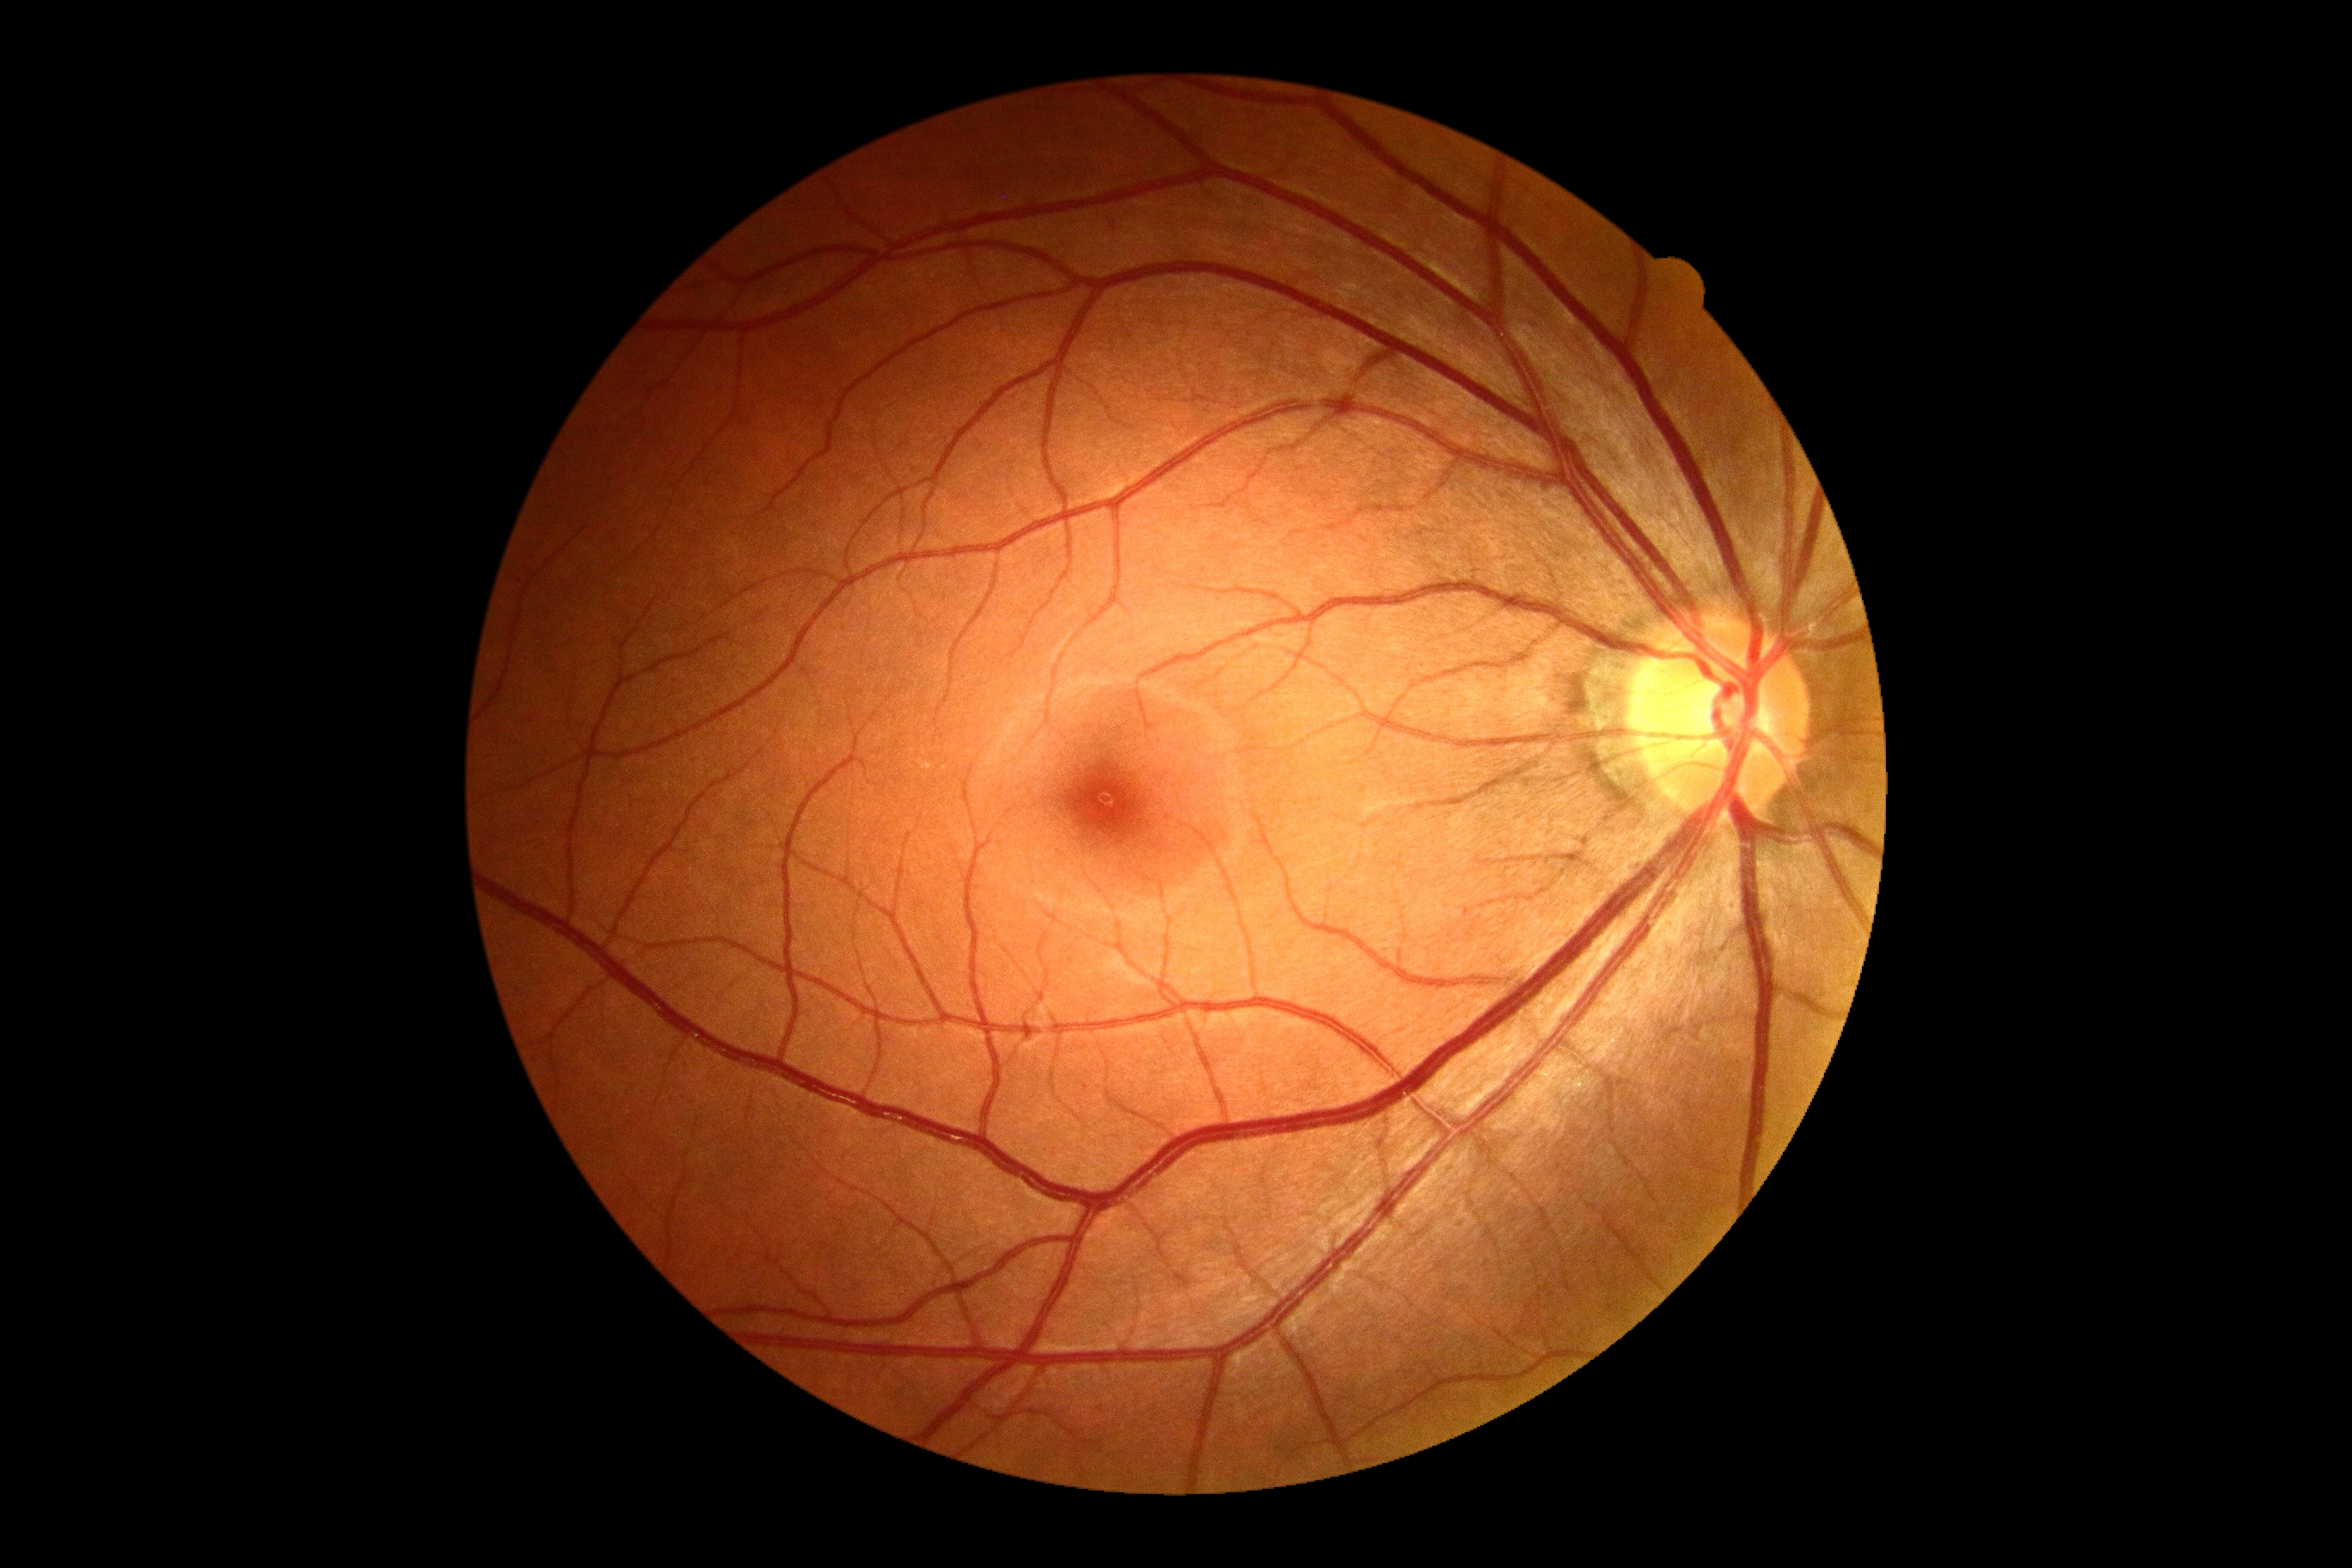

Retinopathy is no apparent retinopathy (grade 0). No diabetic retinal disease findings.